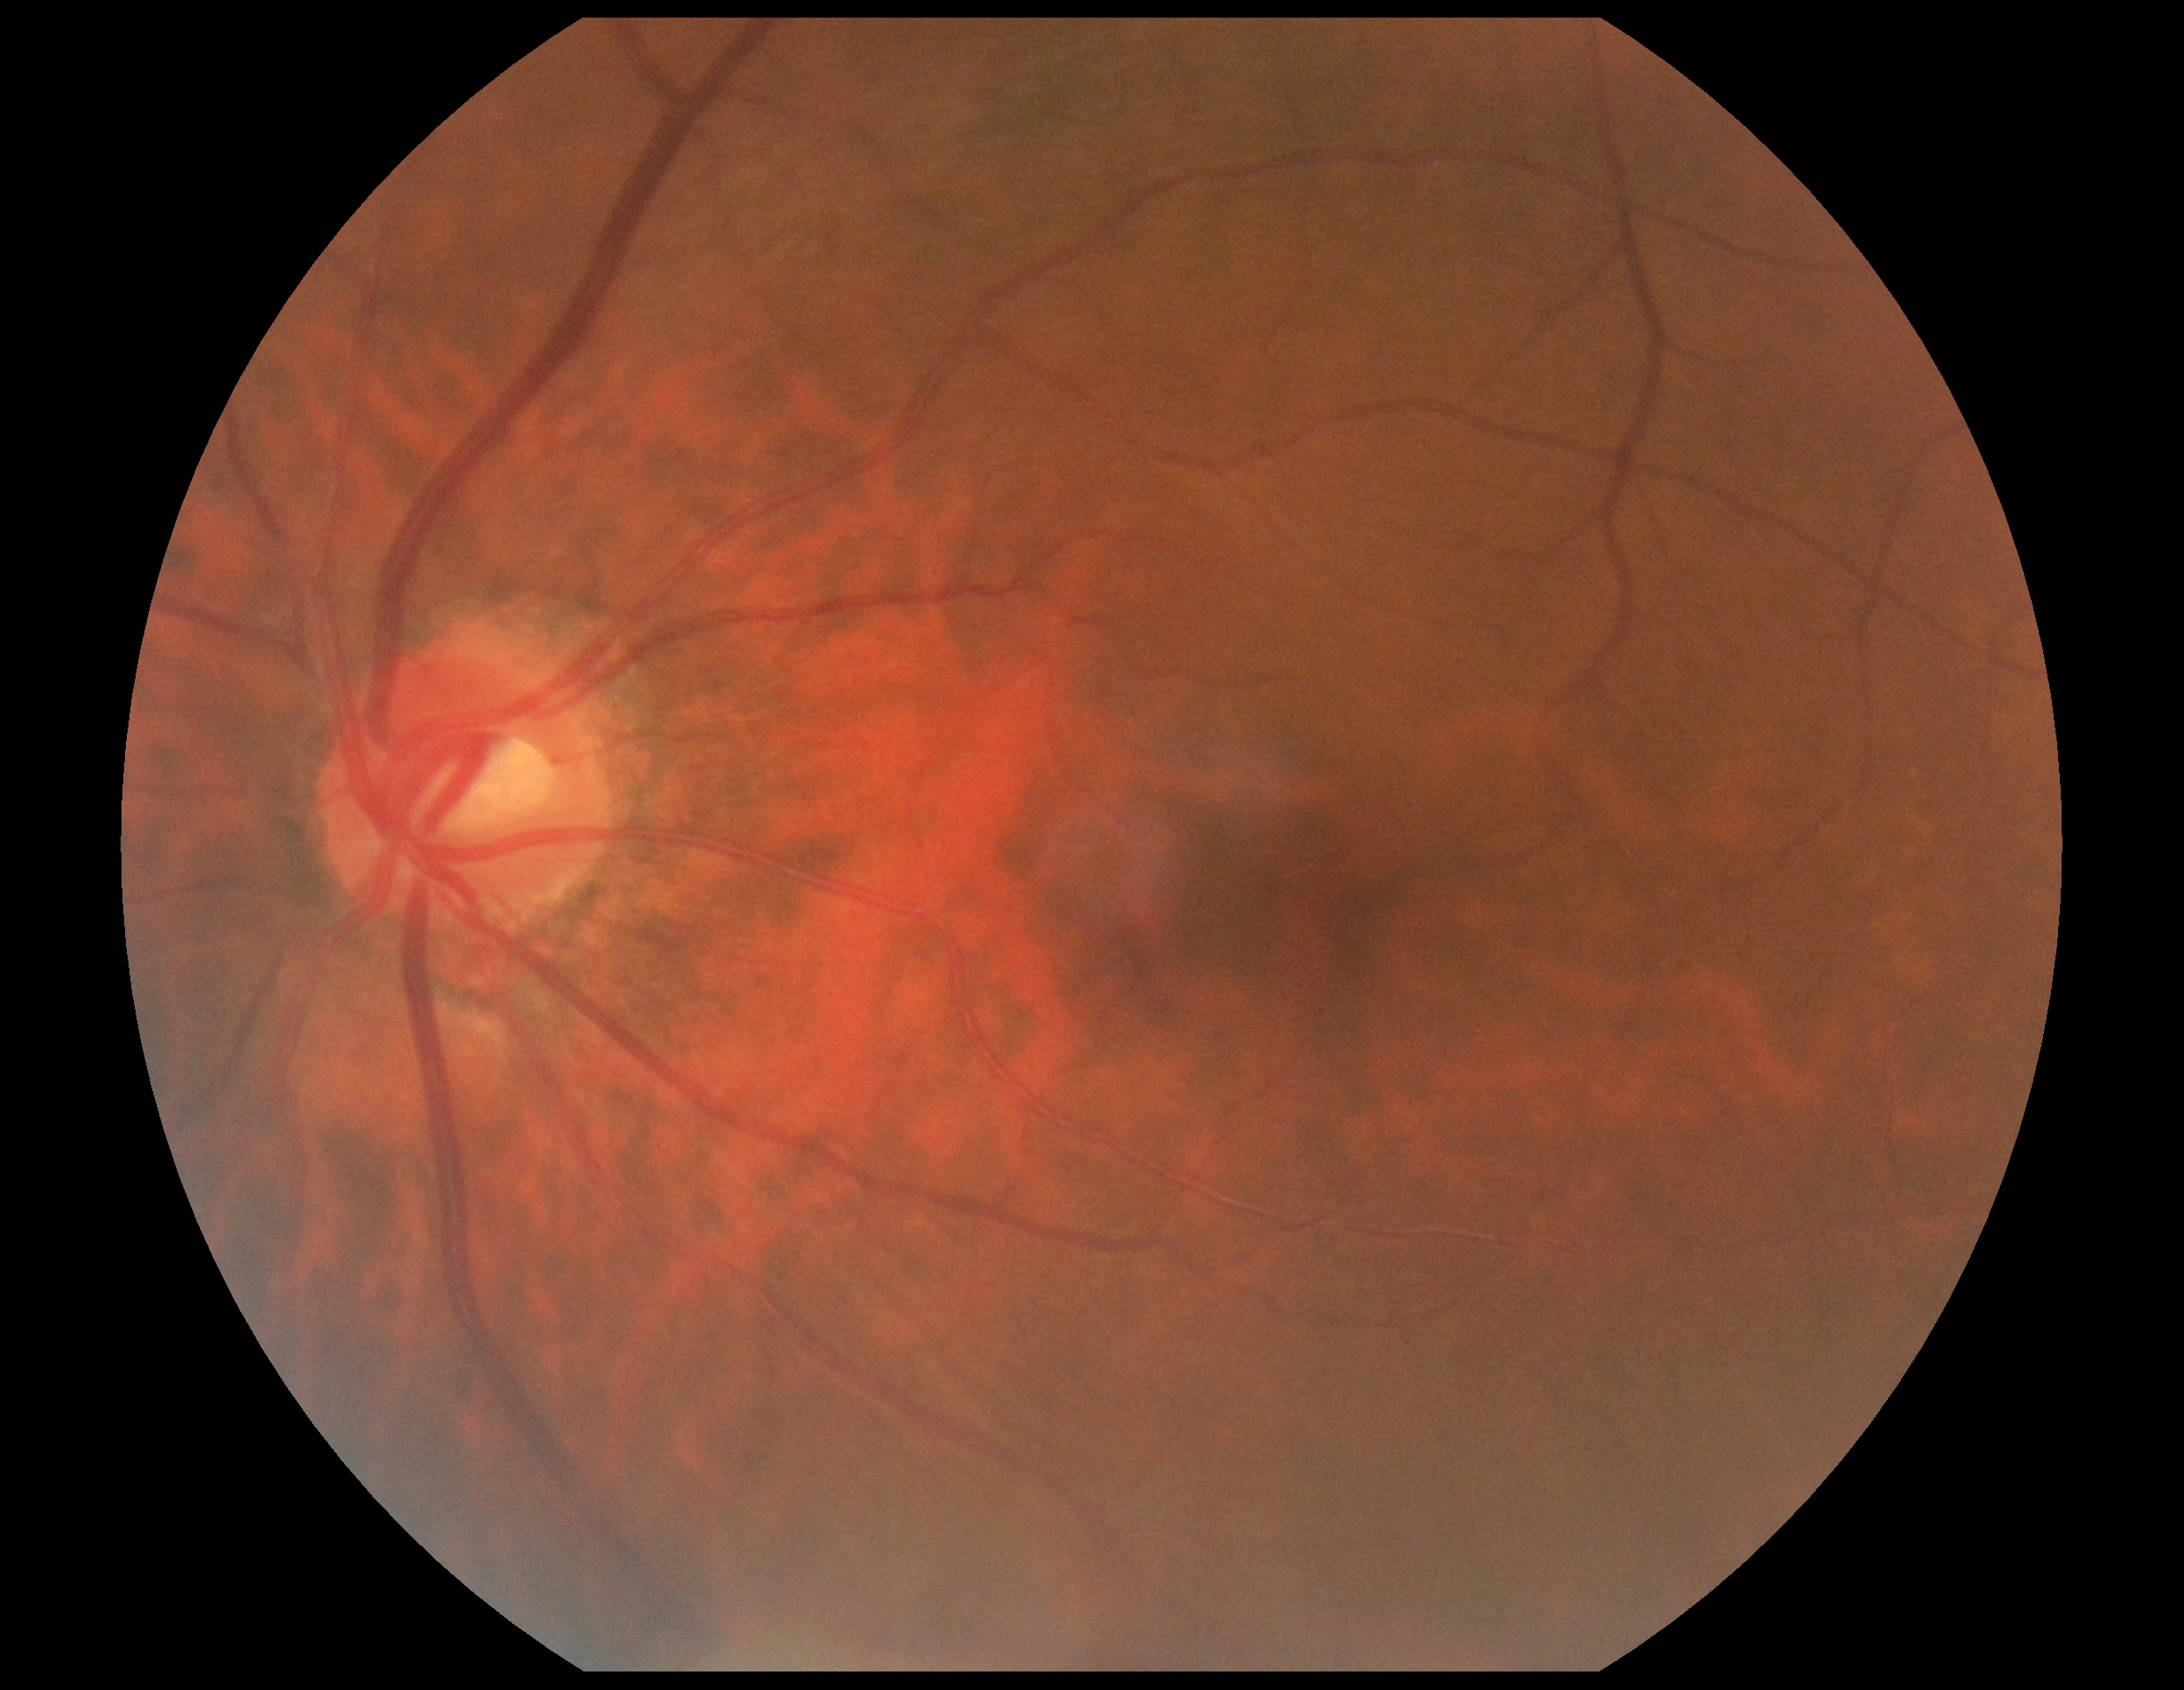

DR impression = no signs of DR
DR stage = grade 0 — no visible signs of diabetic retinopathy